2048x1536px · fundus photo · 45° field of view — 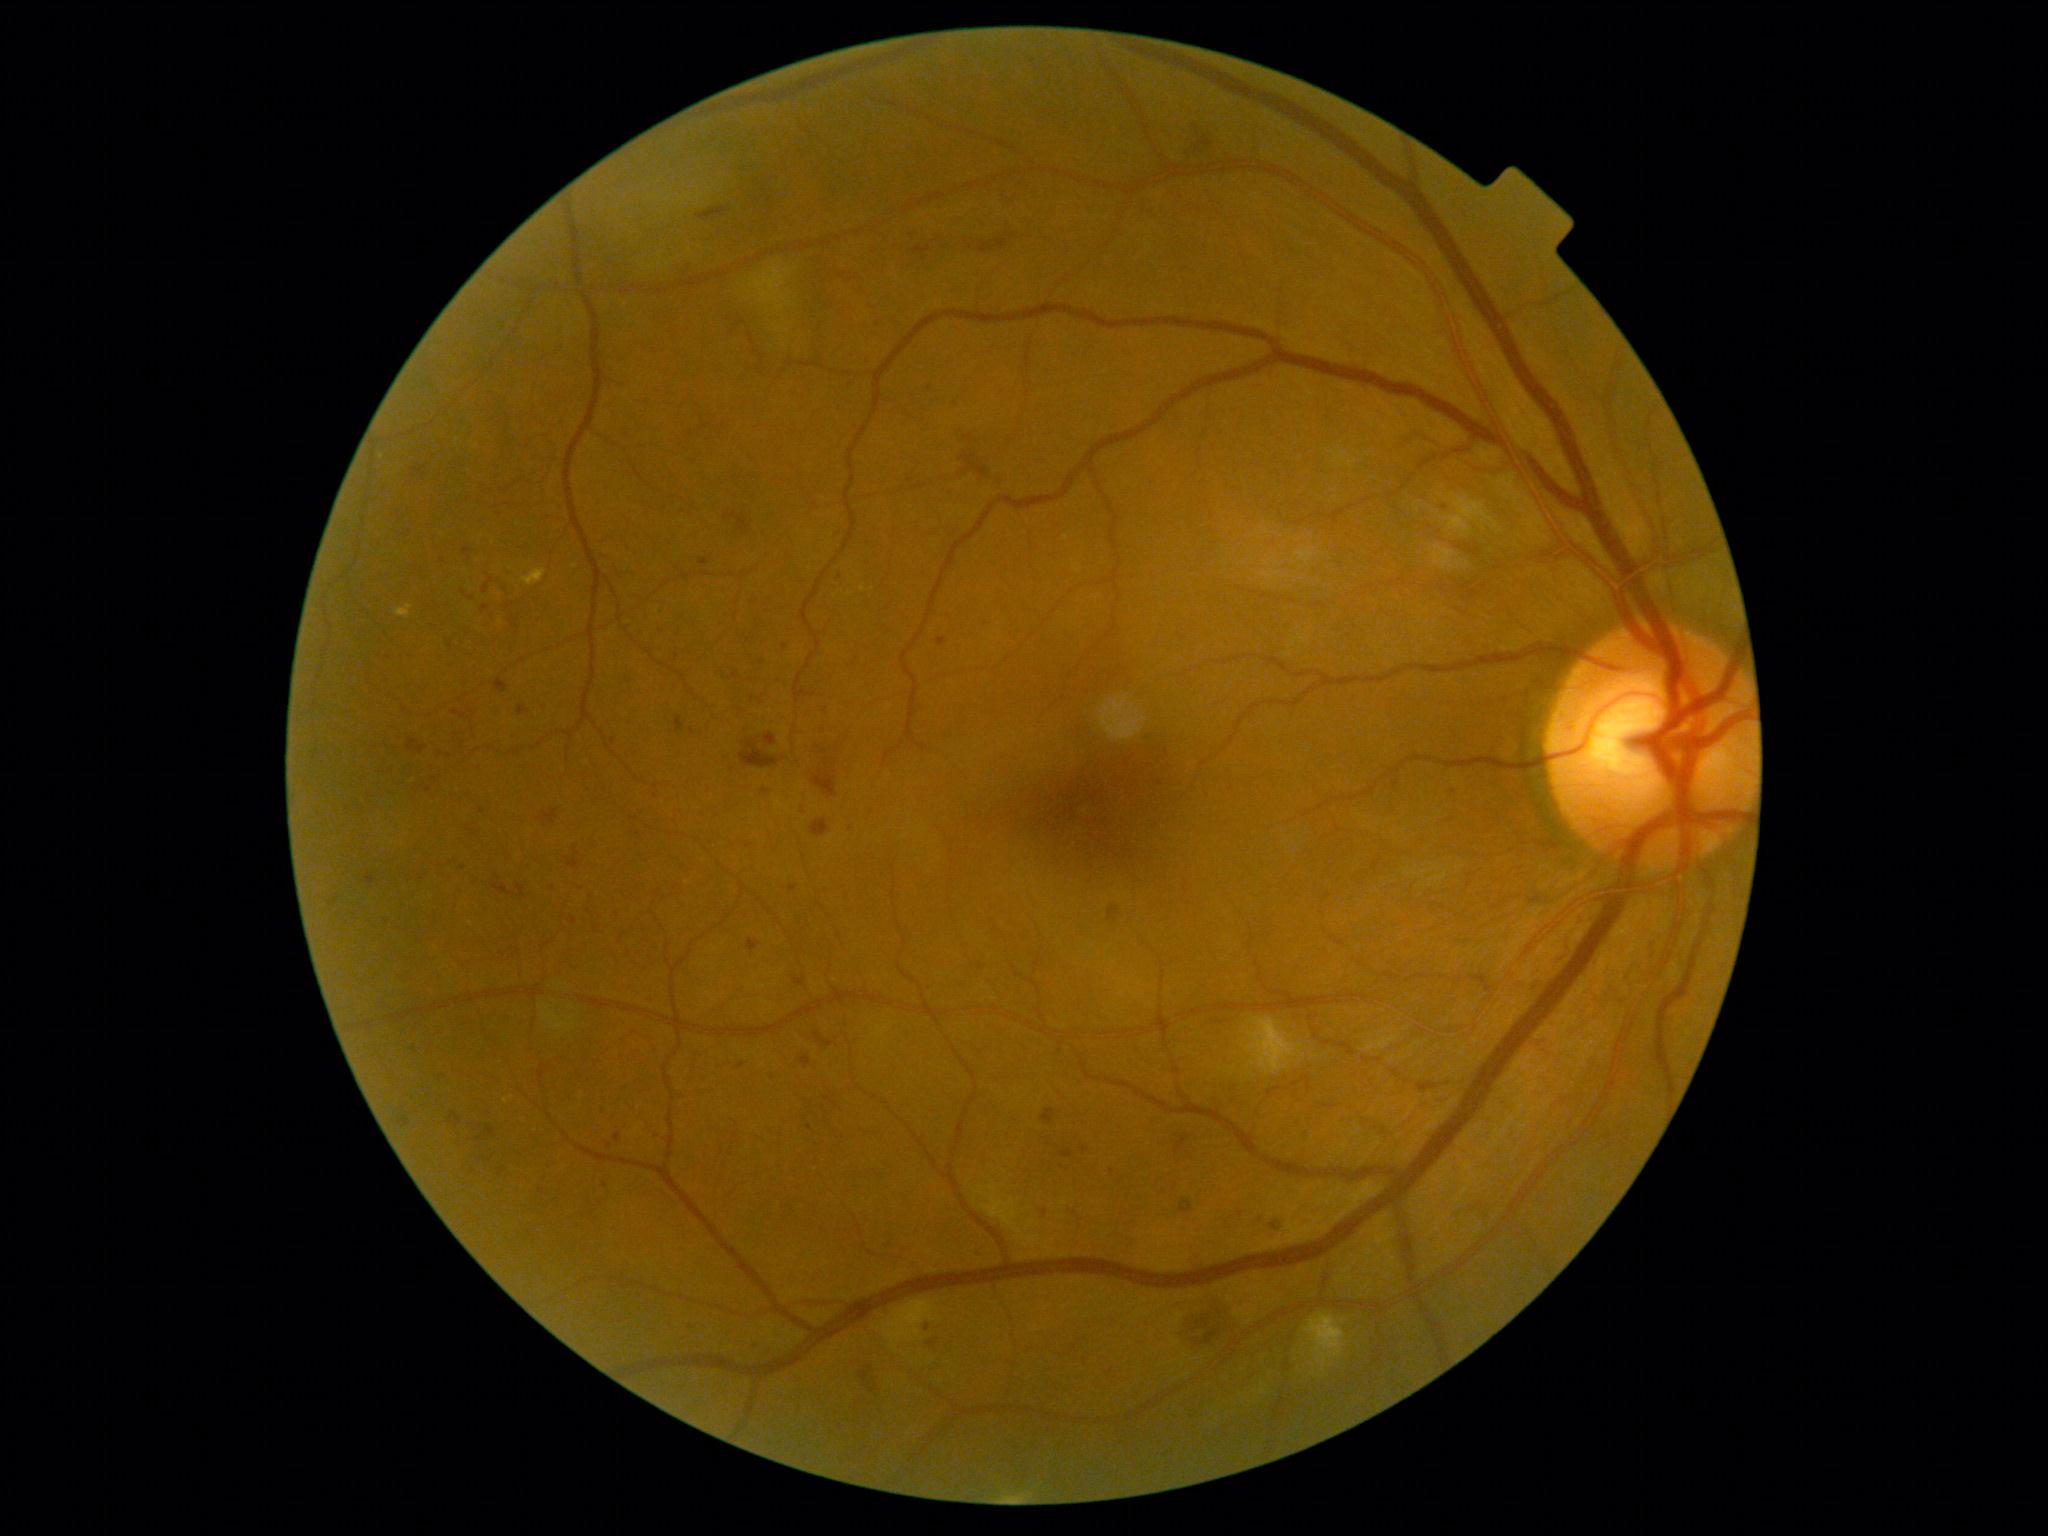
DR grade: 3/4.